Fundus photo
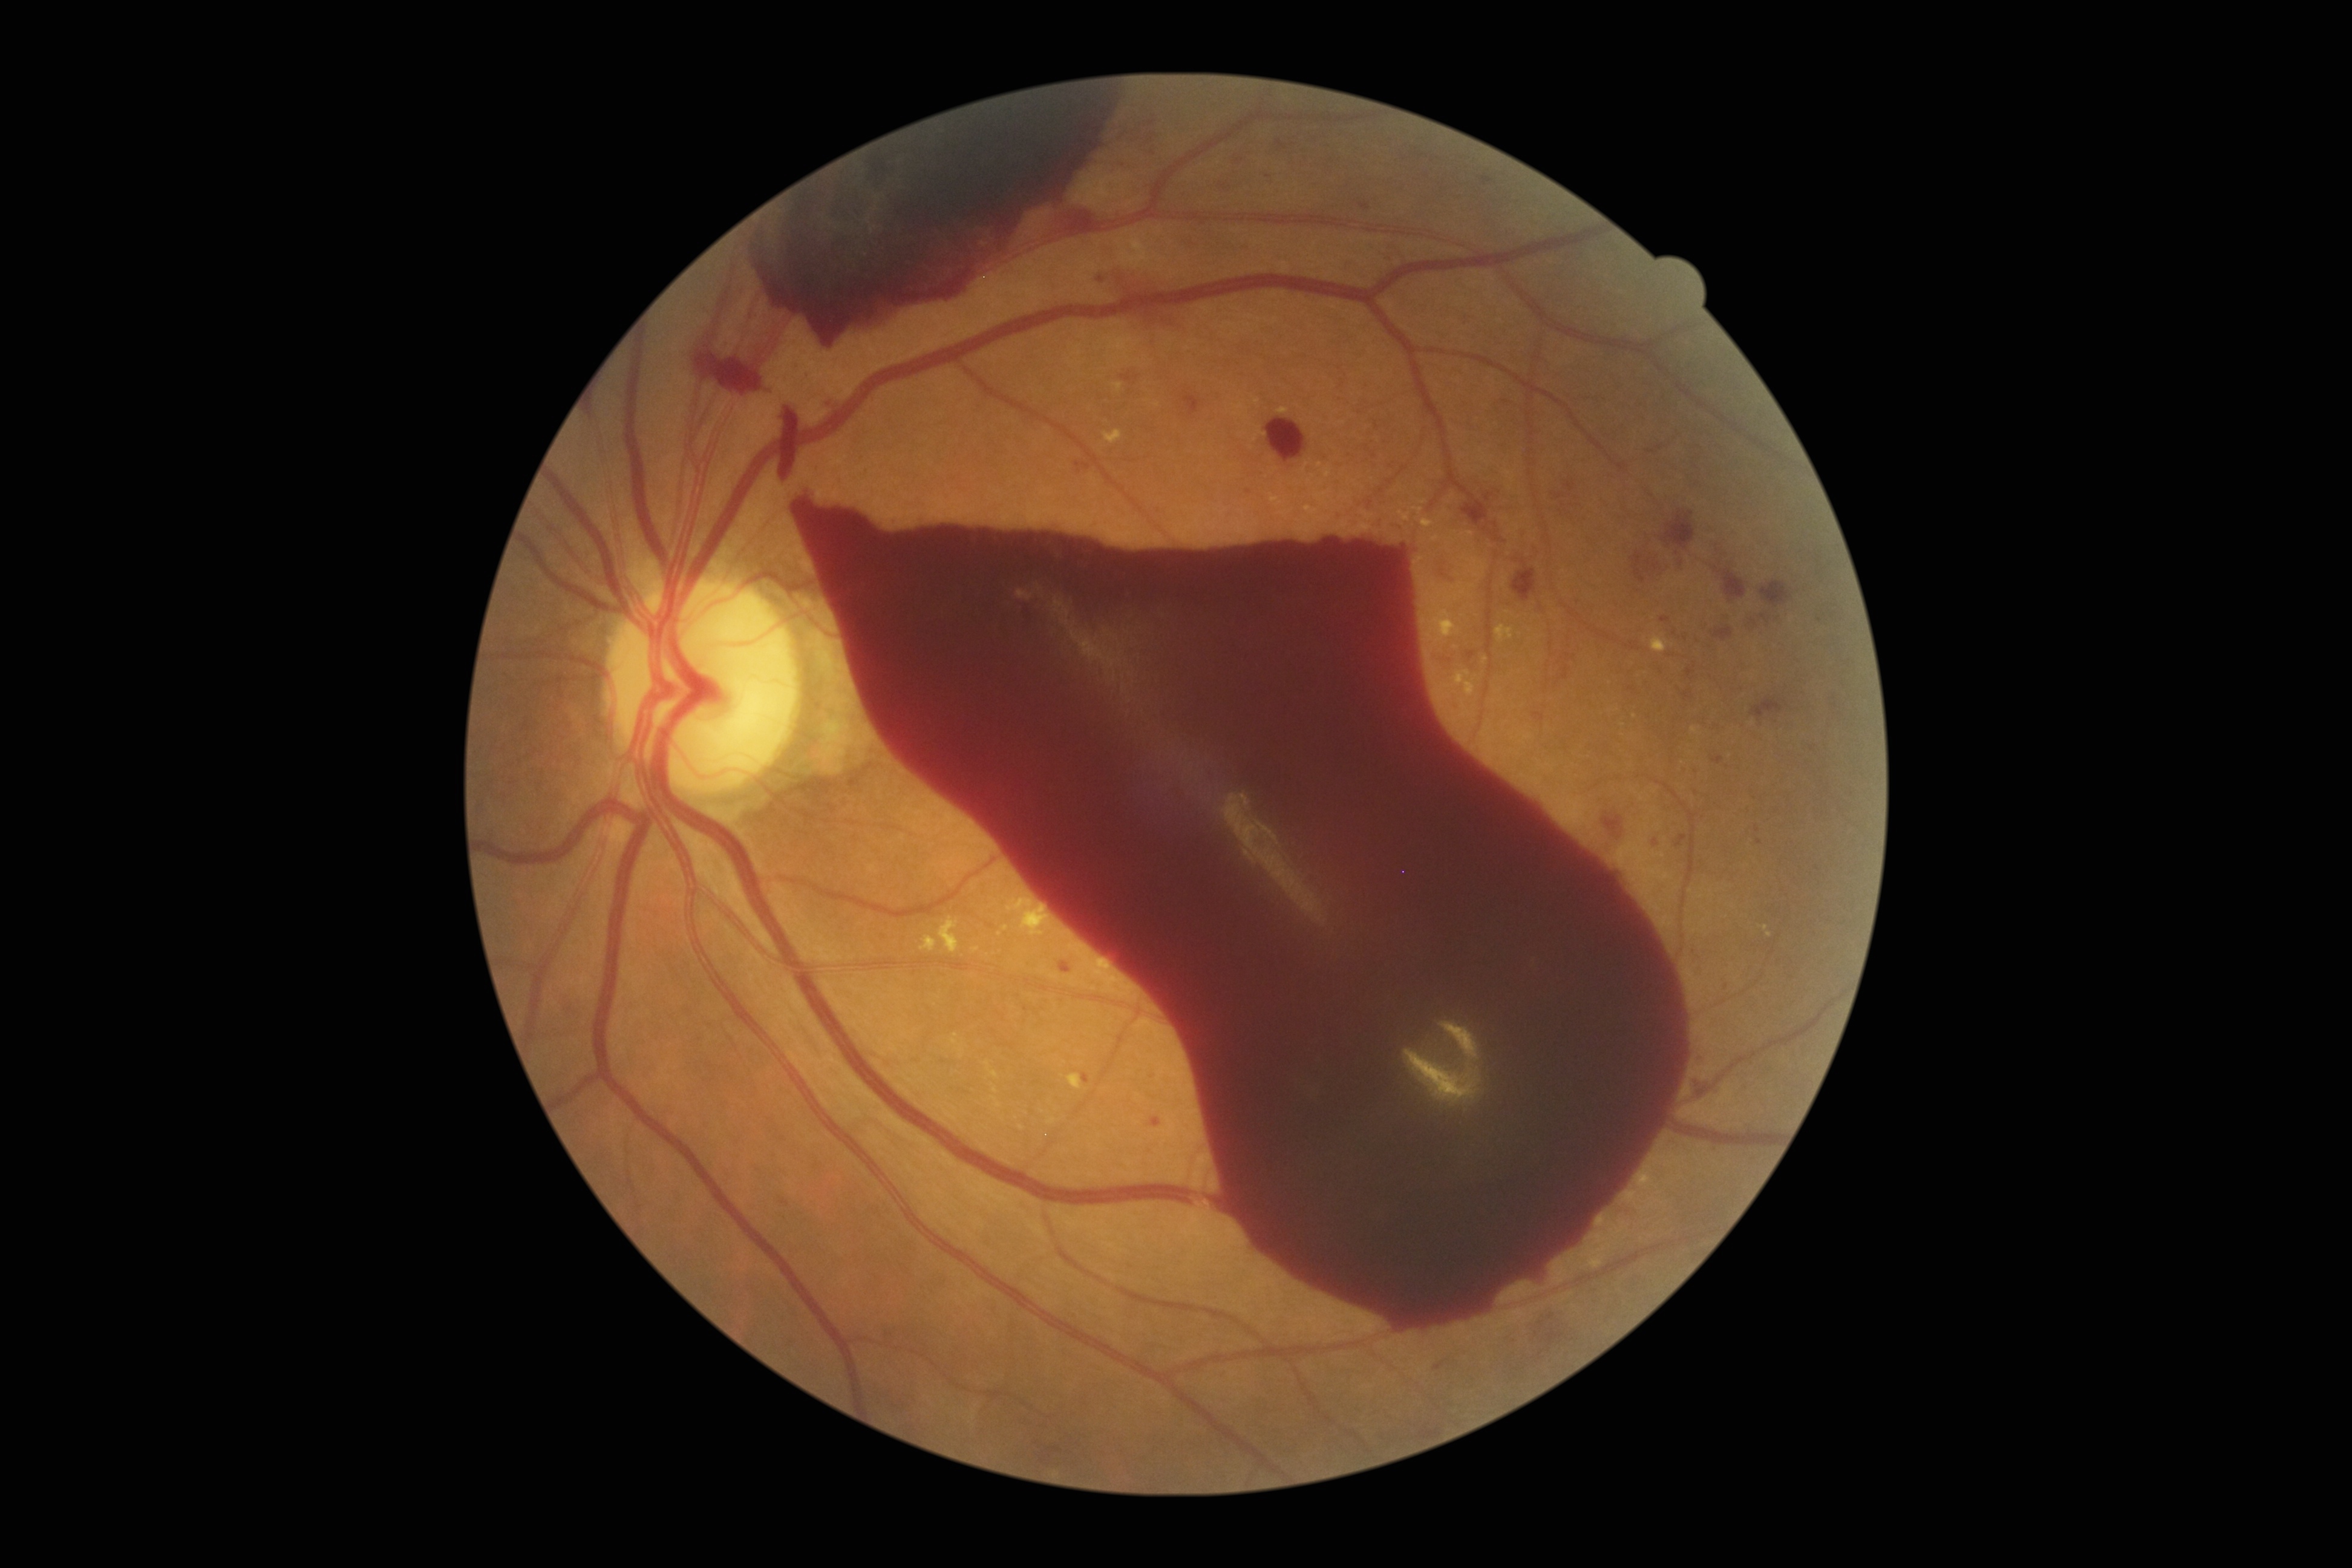 DR stage: grade 4 (PDR).